60° FOV · 2212x1659
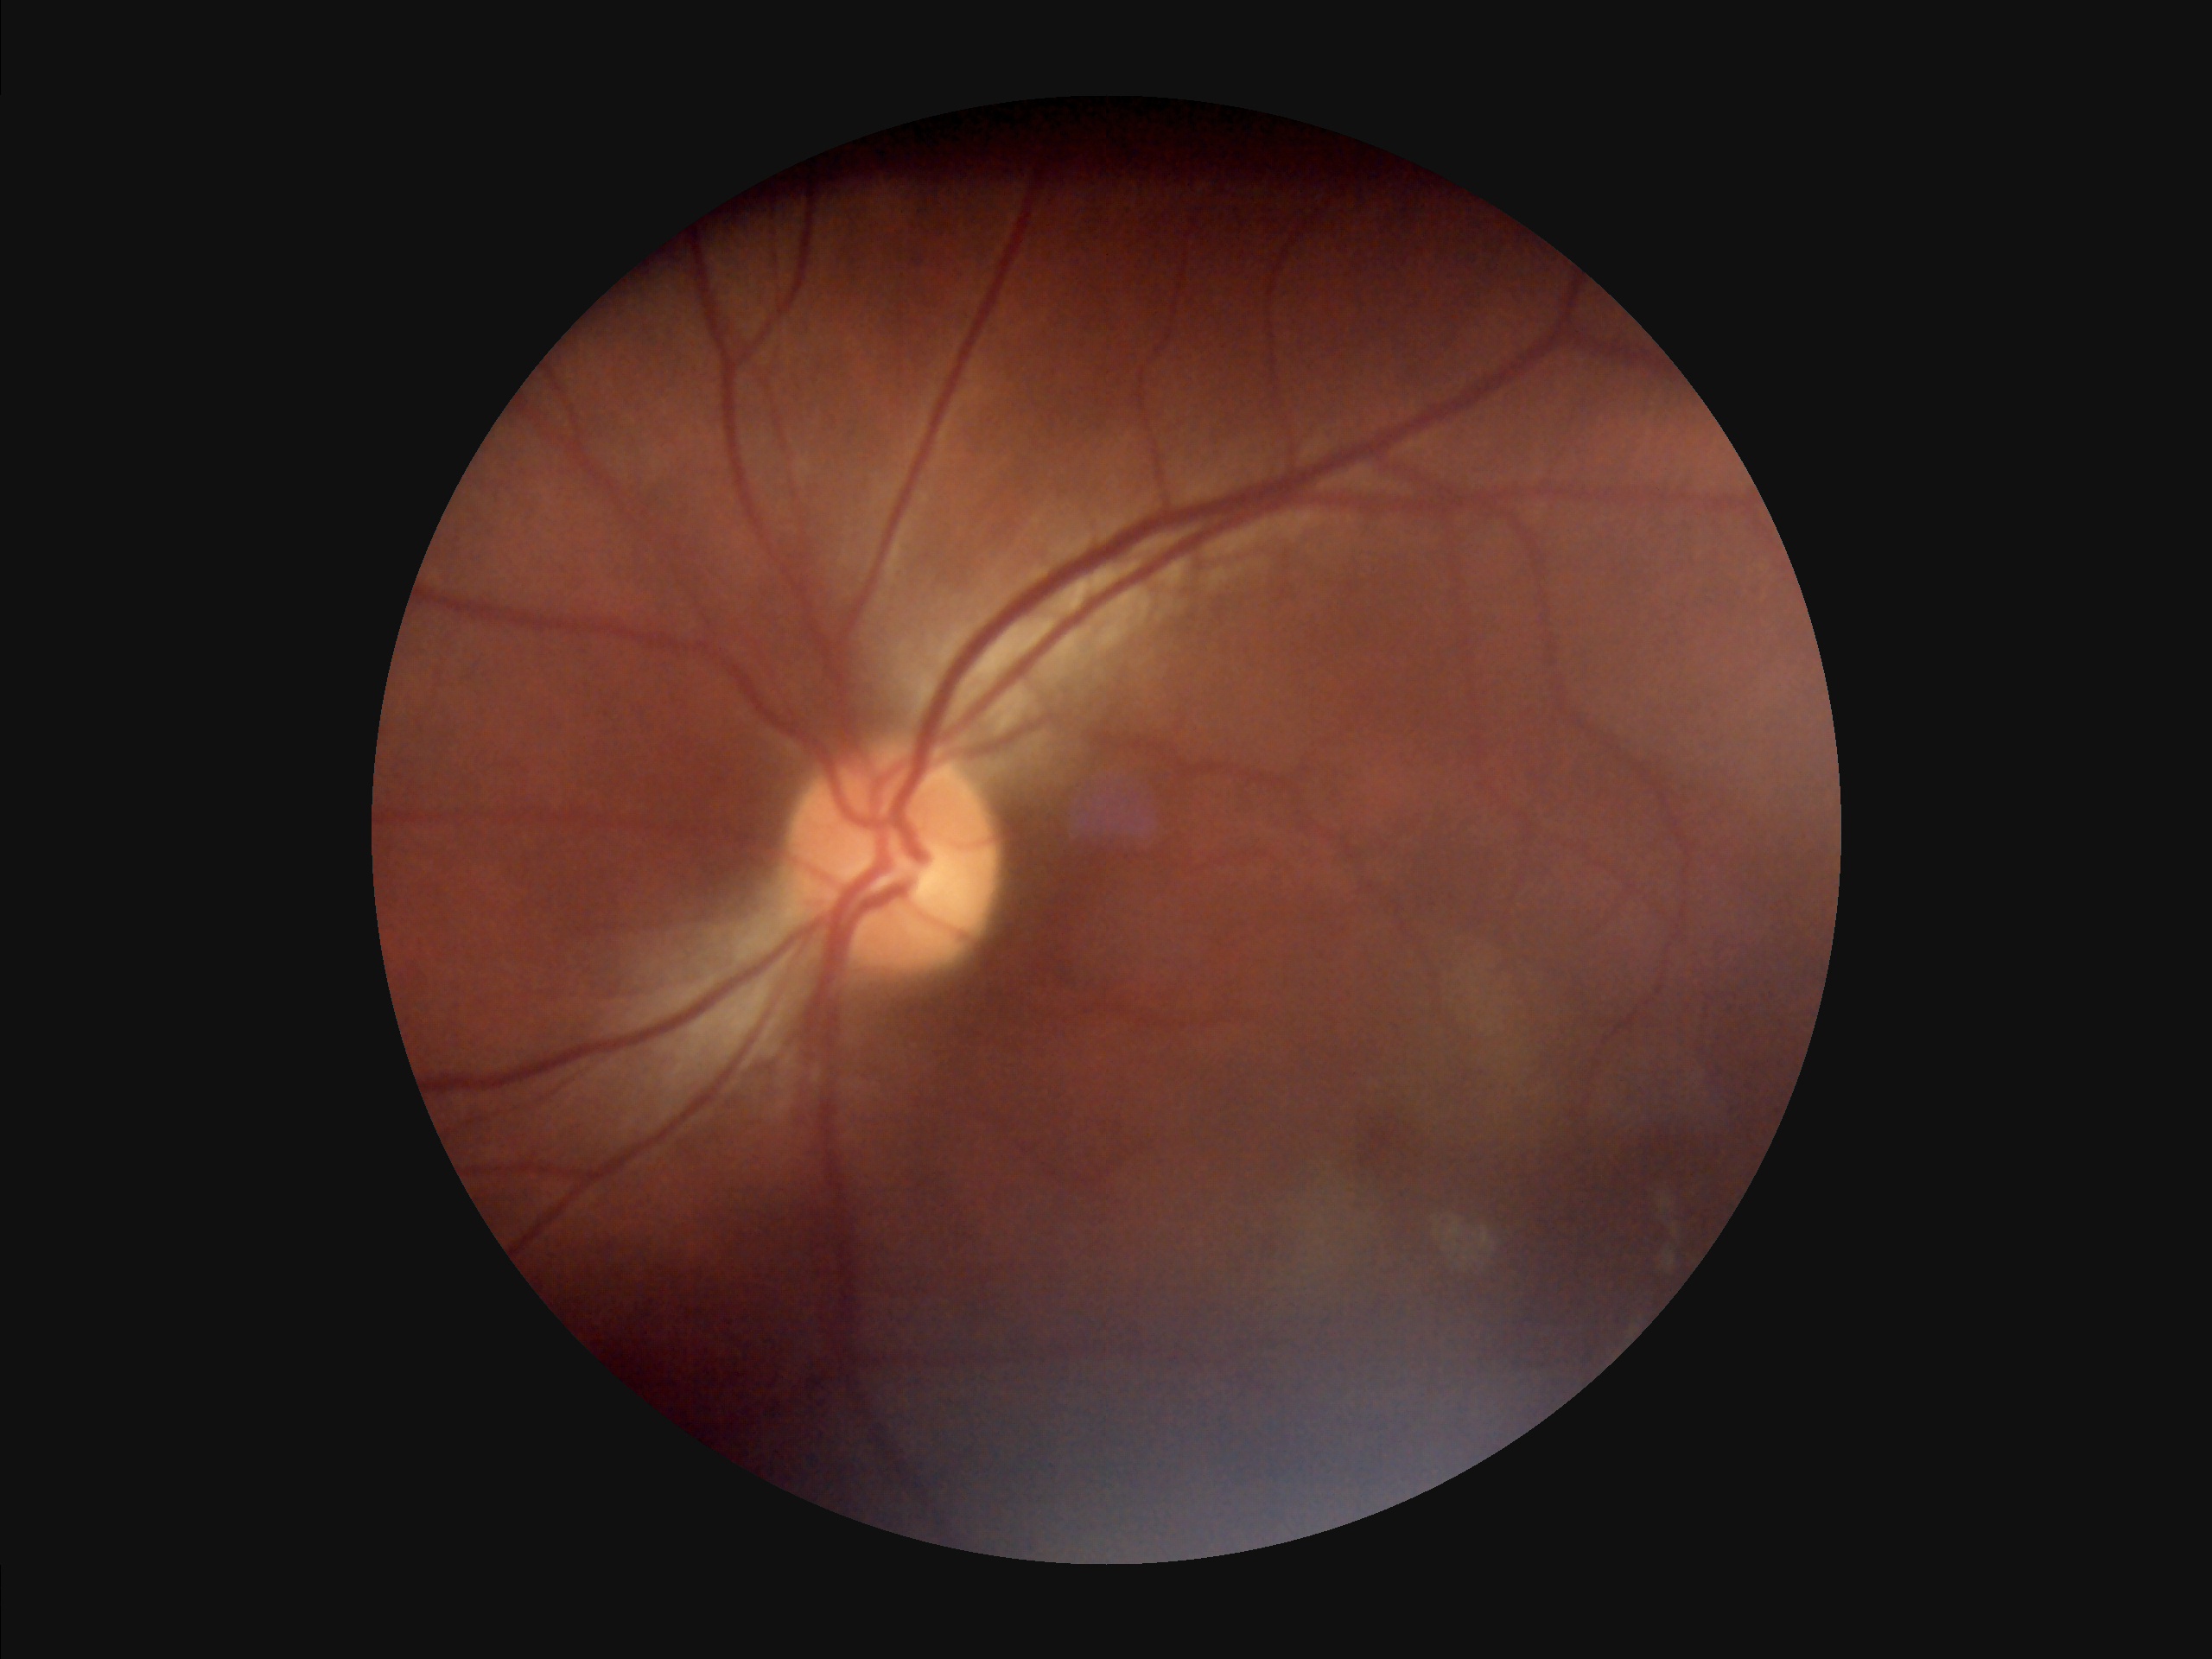

Illumination: uneven illumination or color cast; Focus: noticeable blur in the optic disc, vessels, or background; Contrast: good dynamic range; Overall quality: poor and difficult to use diagnostically.